2212x1659px; 45-degree field of view:
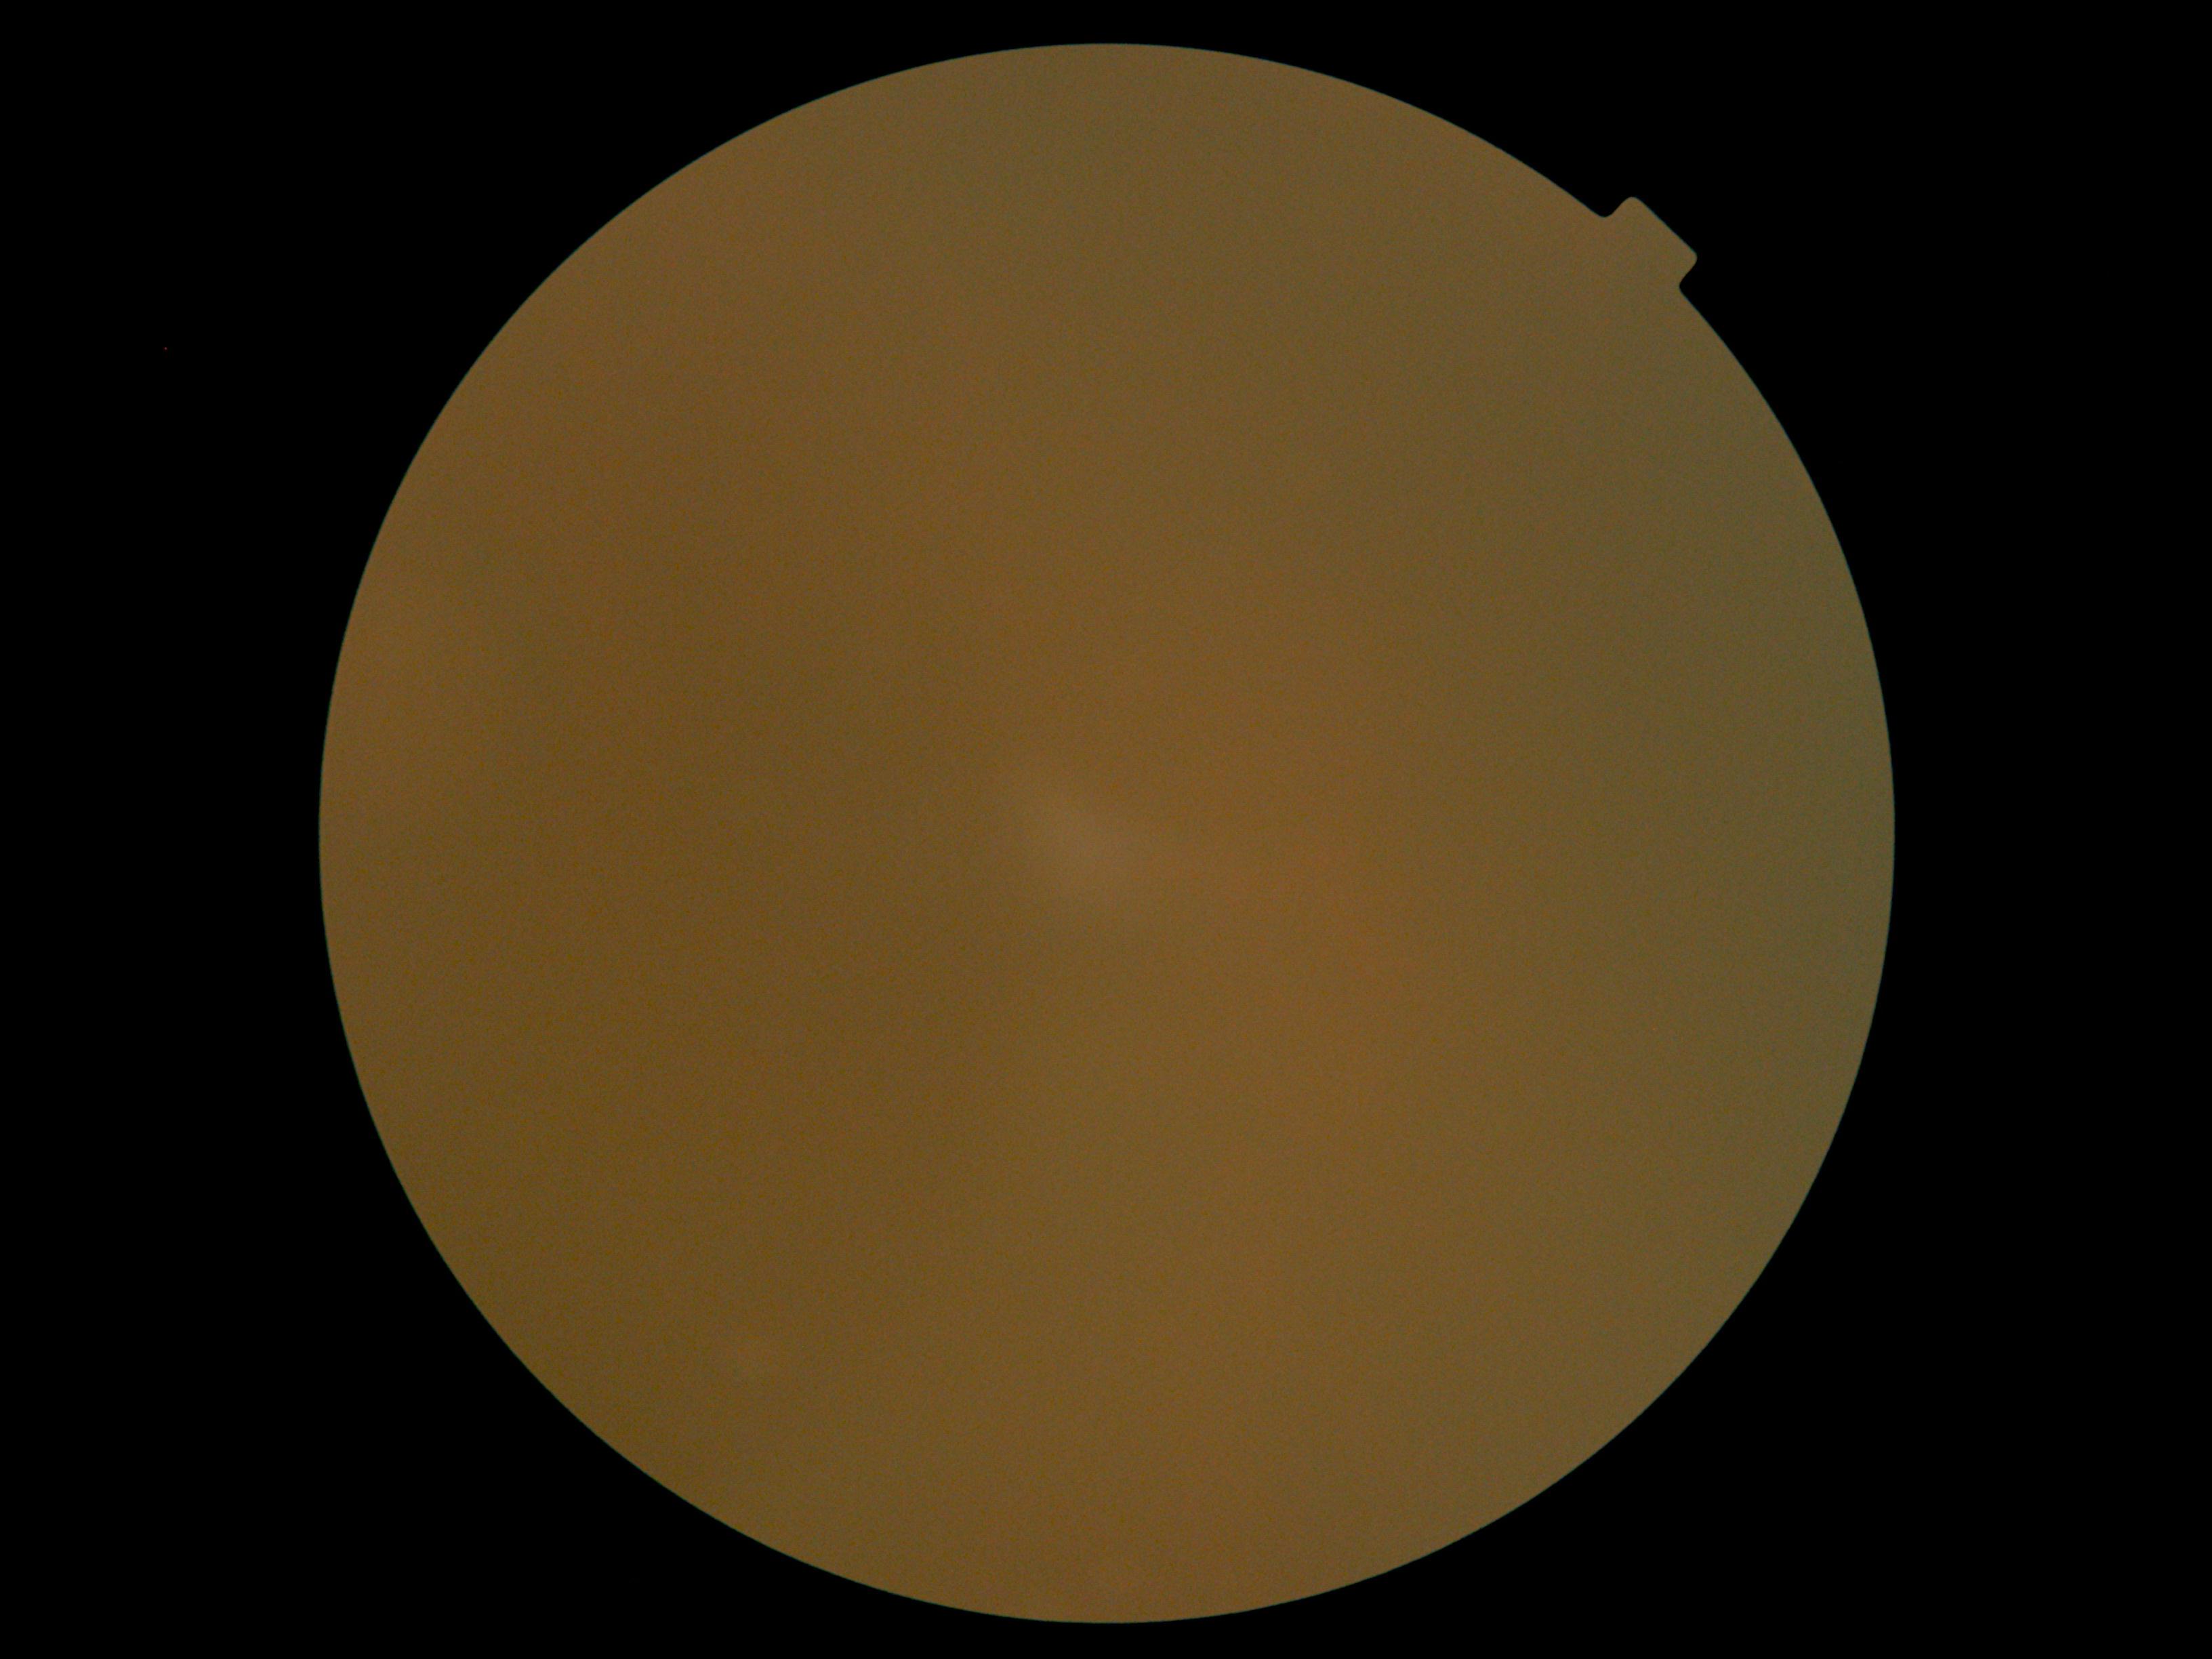
Diabetic retinopathy (DR): ungradable.